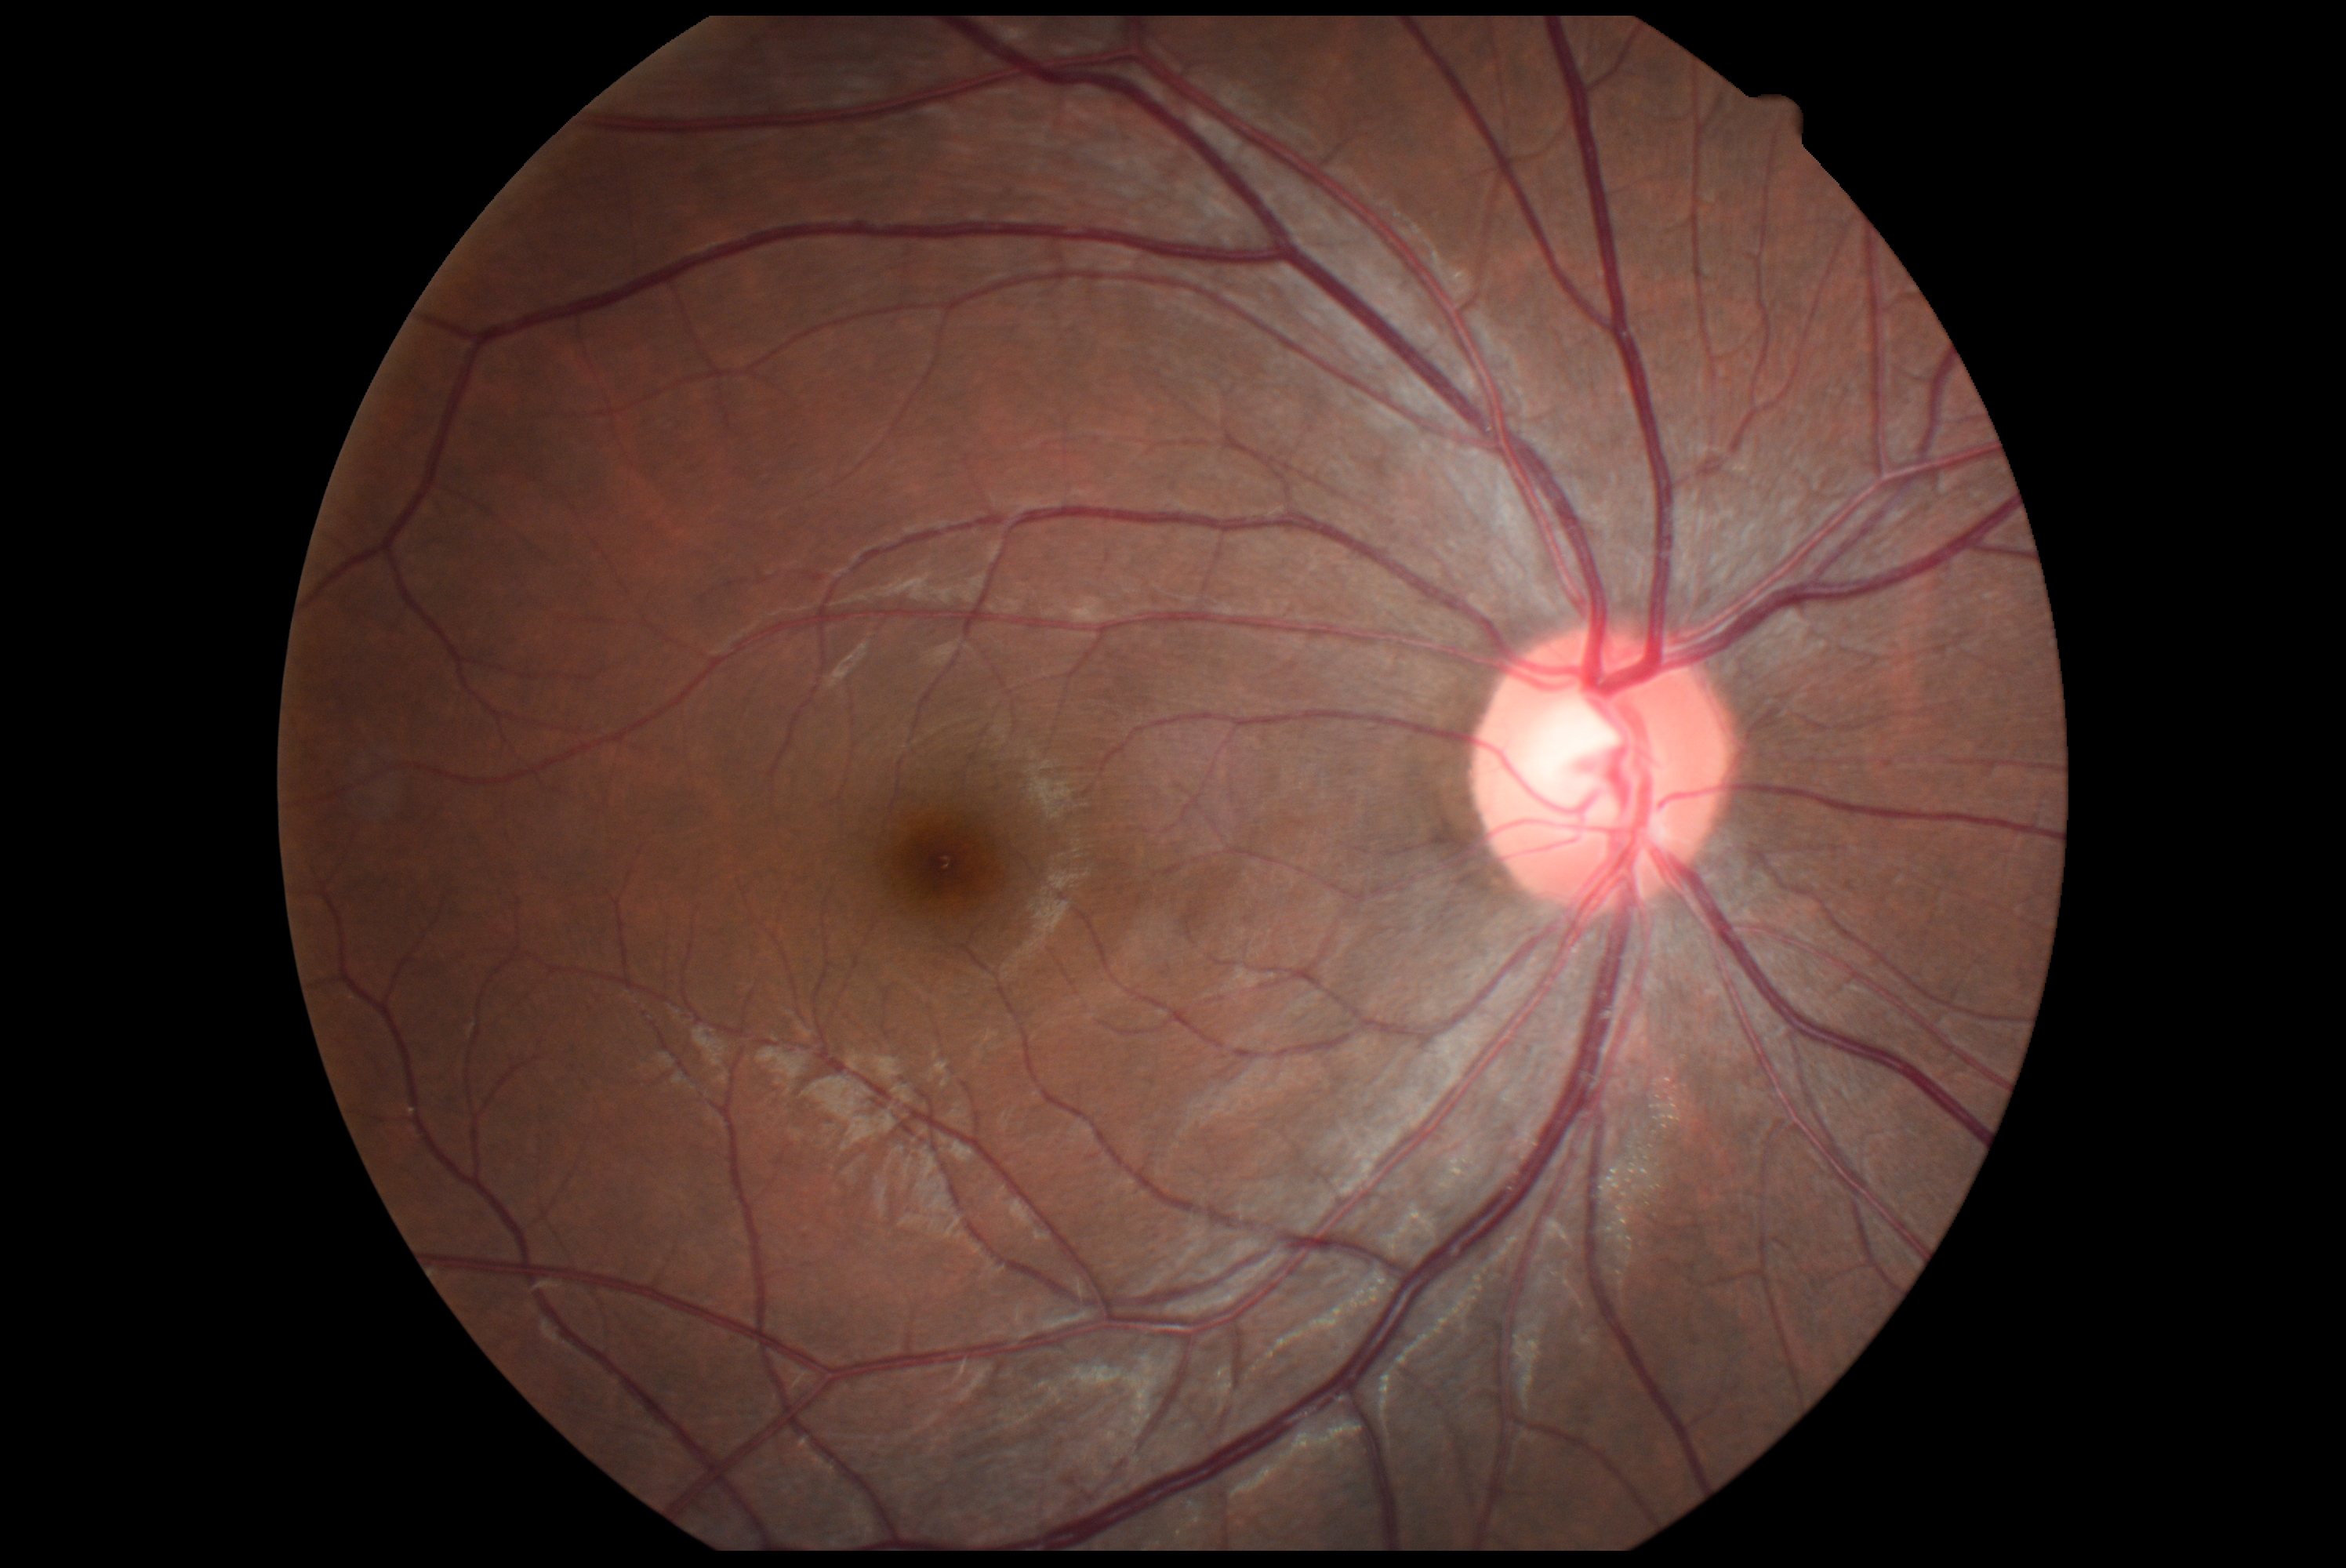
No signs of diabetic retinopathy. Retinopathy: 0.